Captured with the Phoenix ICON (100° field of view); 1240x1240; Phoenix ICON wide-field infant fundus image:
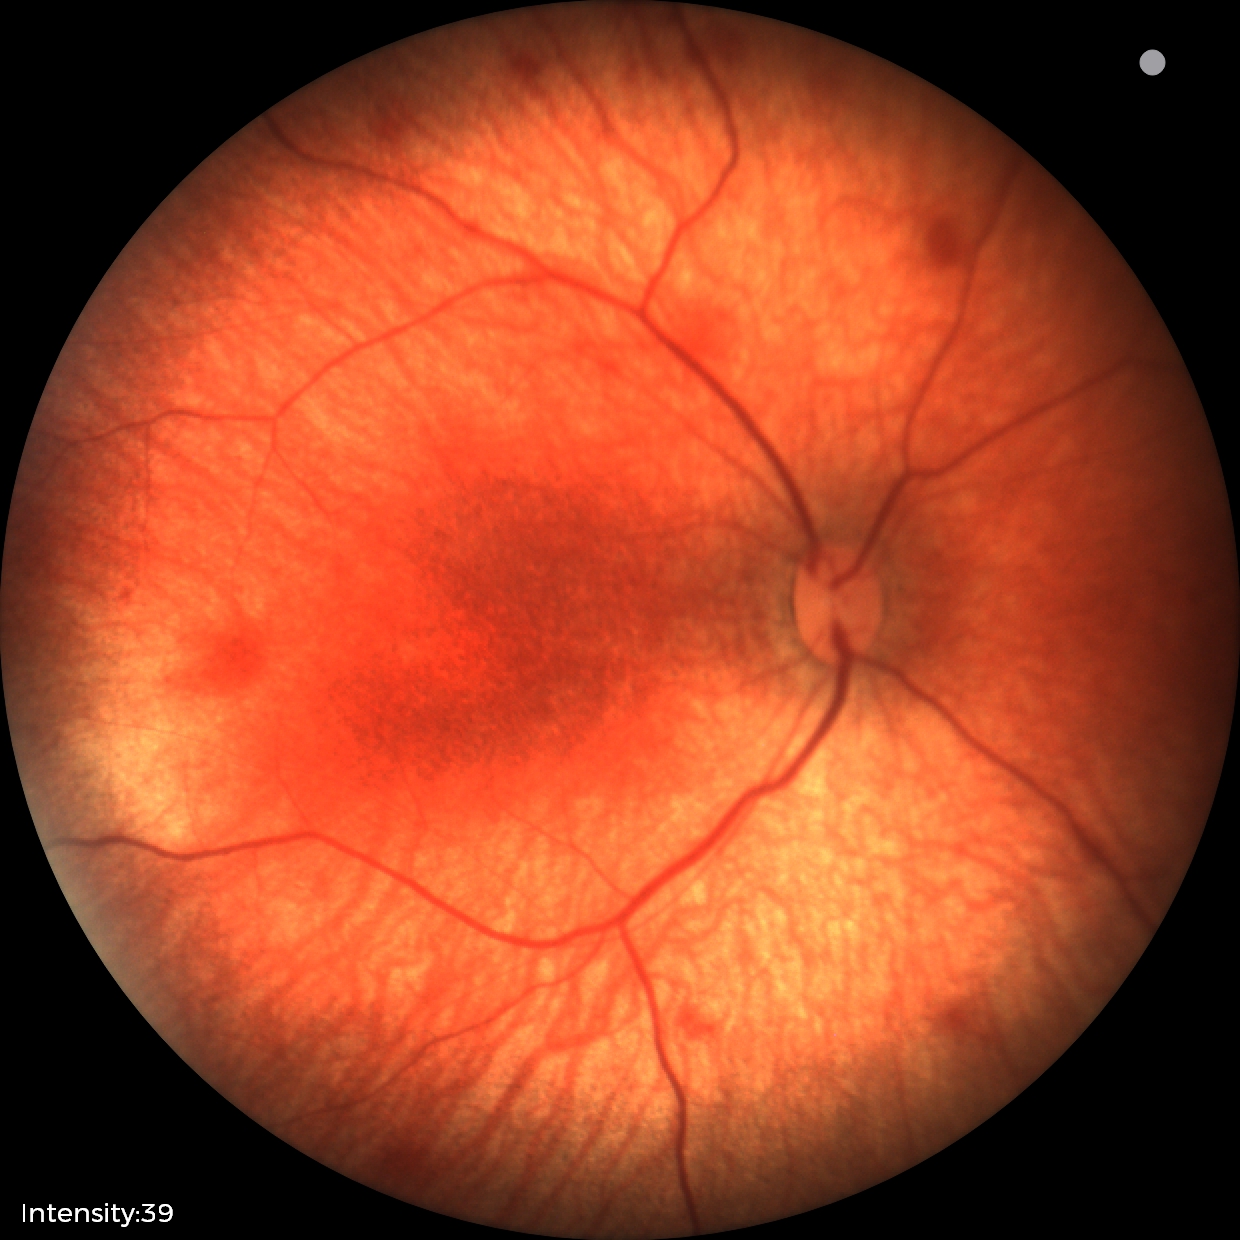
Diagnosis from this screening exam: retinal hemorrhages.